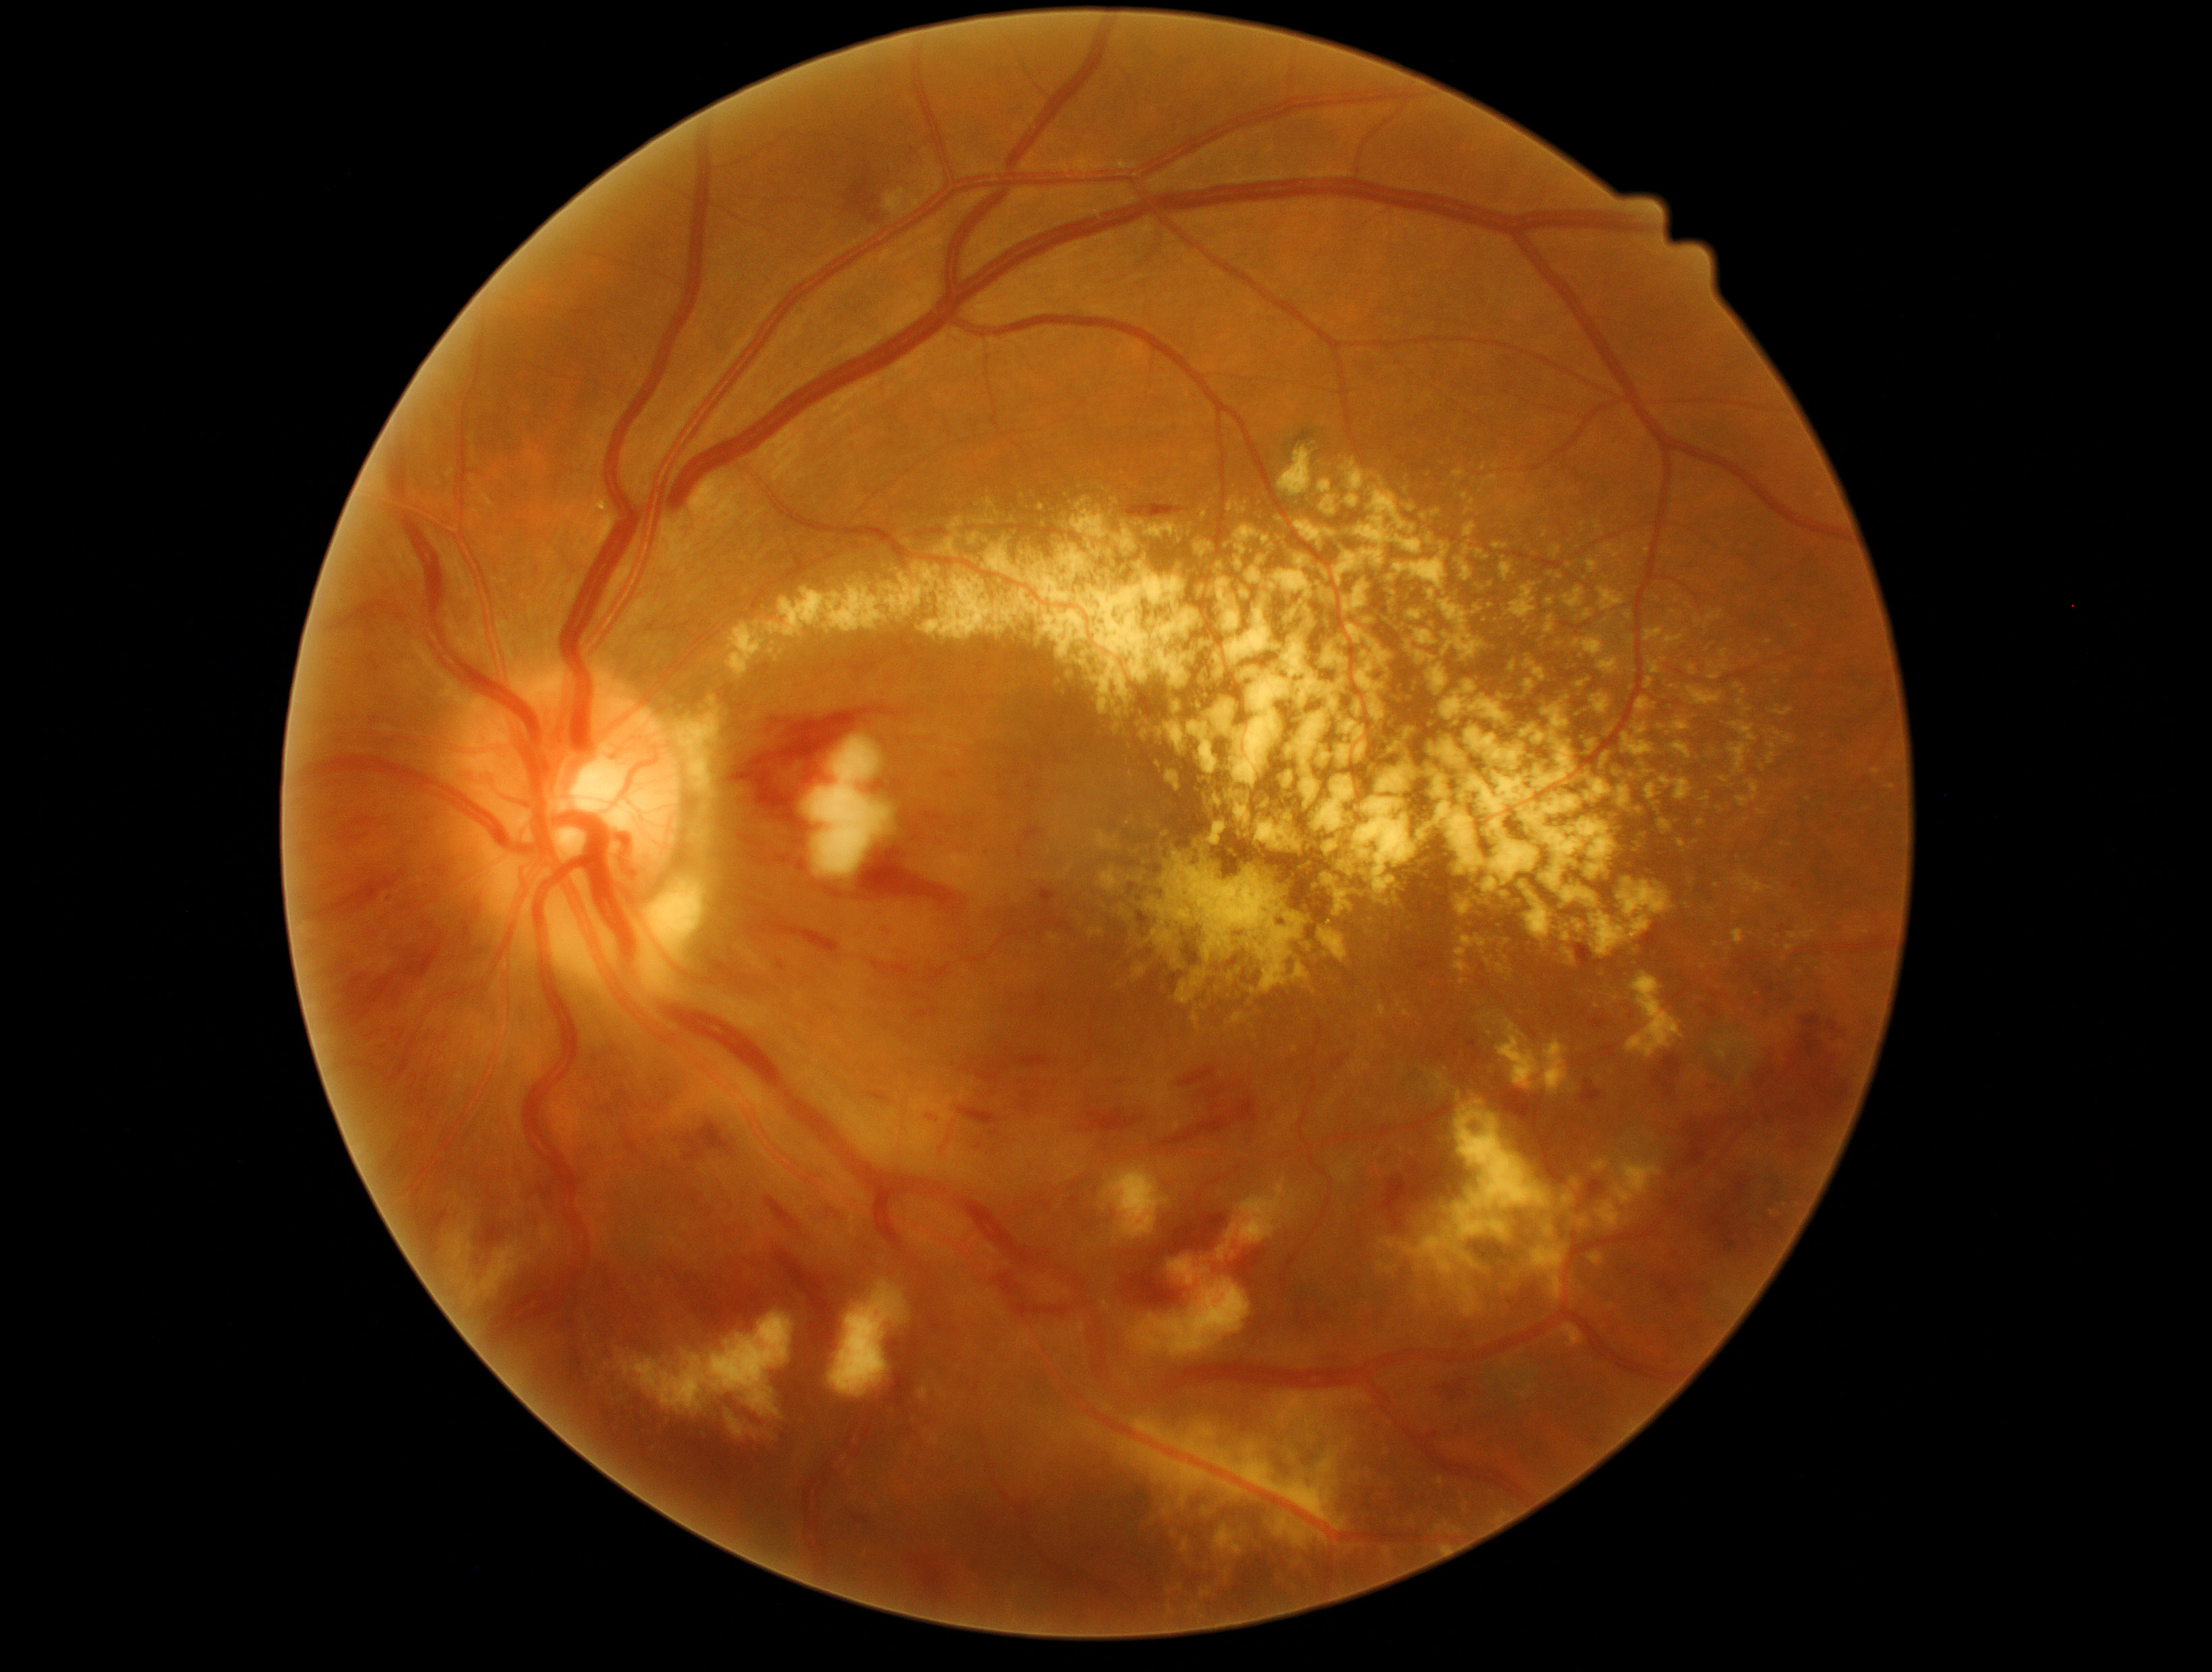

Diabetic retinopathy (DR) is grade 3 (severe NPDR).
Hard exudates (EXs) include lesions at <bbox>1192, 1012, 1201, 1032</bbox>; <bbox>1572, 1179, 1580, 1189</bbox>; <bbox>1325, 721, 1422, 909</bbox>; <bbox>1131, 966, 1147, 982</bbox>; <bbox>1232, 1013, 1244, 1024</bbox>; <bbox>1177, 969, 1209, 1004</bbox>; <bbox>1490, 601, 1498, 613</bbox>; <bbox>672, 696, 721, 800</bbox>; <bbox>1053, 505, 1069, 532</bbox>; <bbox>1521, 622, 1533, 641</bbox>; <bbox>693, 826, 714, 852</bbox>; <bbox>1612, 1156, 1662, 1206</bbox>; <bbox>1734, 872, 1772, 896</bbox>; <bbox>1544, 567, 1568, 580</bbox>; <bbox>1688, 690, 1726, 707</bbox>; <bbox>1348, 1469, 1391, 1505</bbox>.
Small EXs near [1783,959]; [1165,834]; [1012,521].